Pediatric retinal photograph (wide-field)
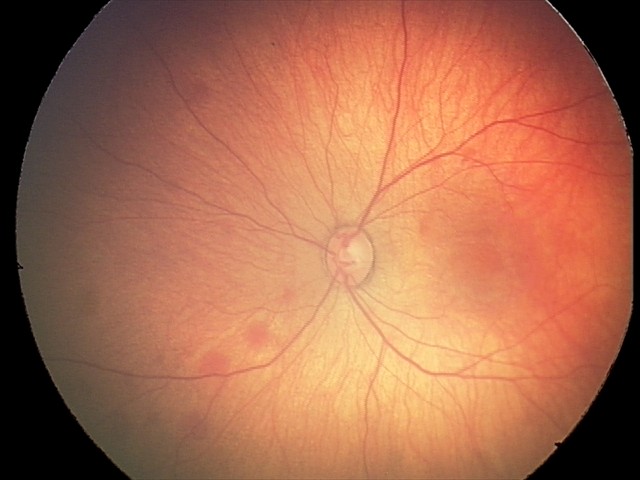
Screening series with retinal hemorrhages.